Color fundus photograph; 45° FOV
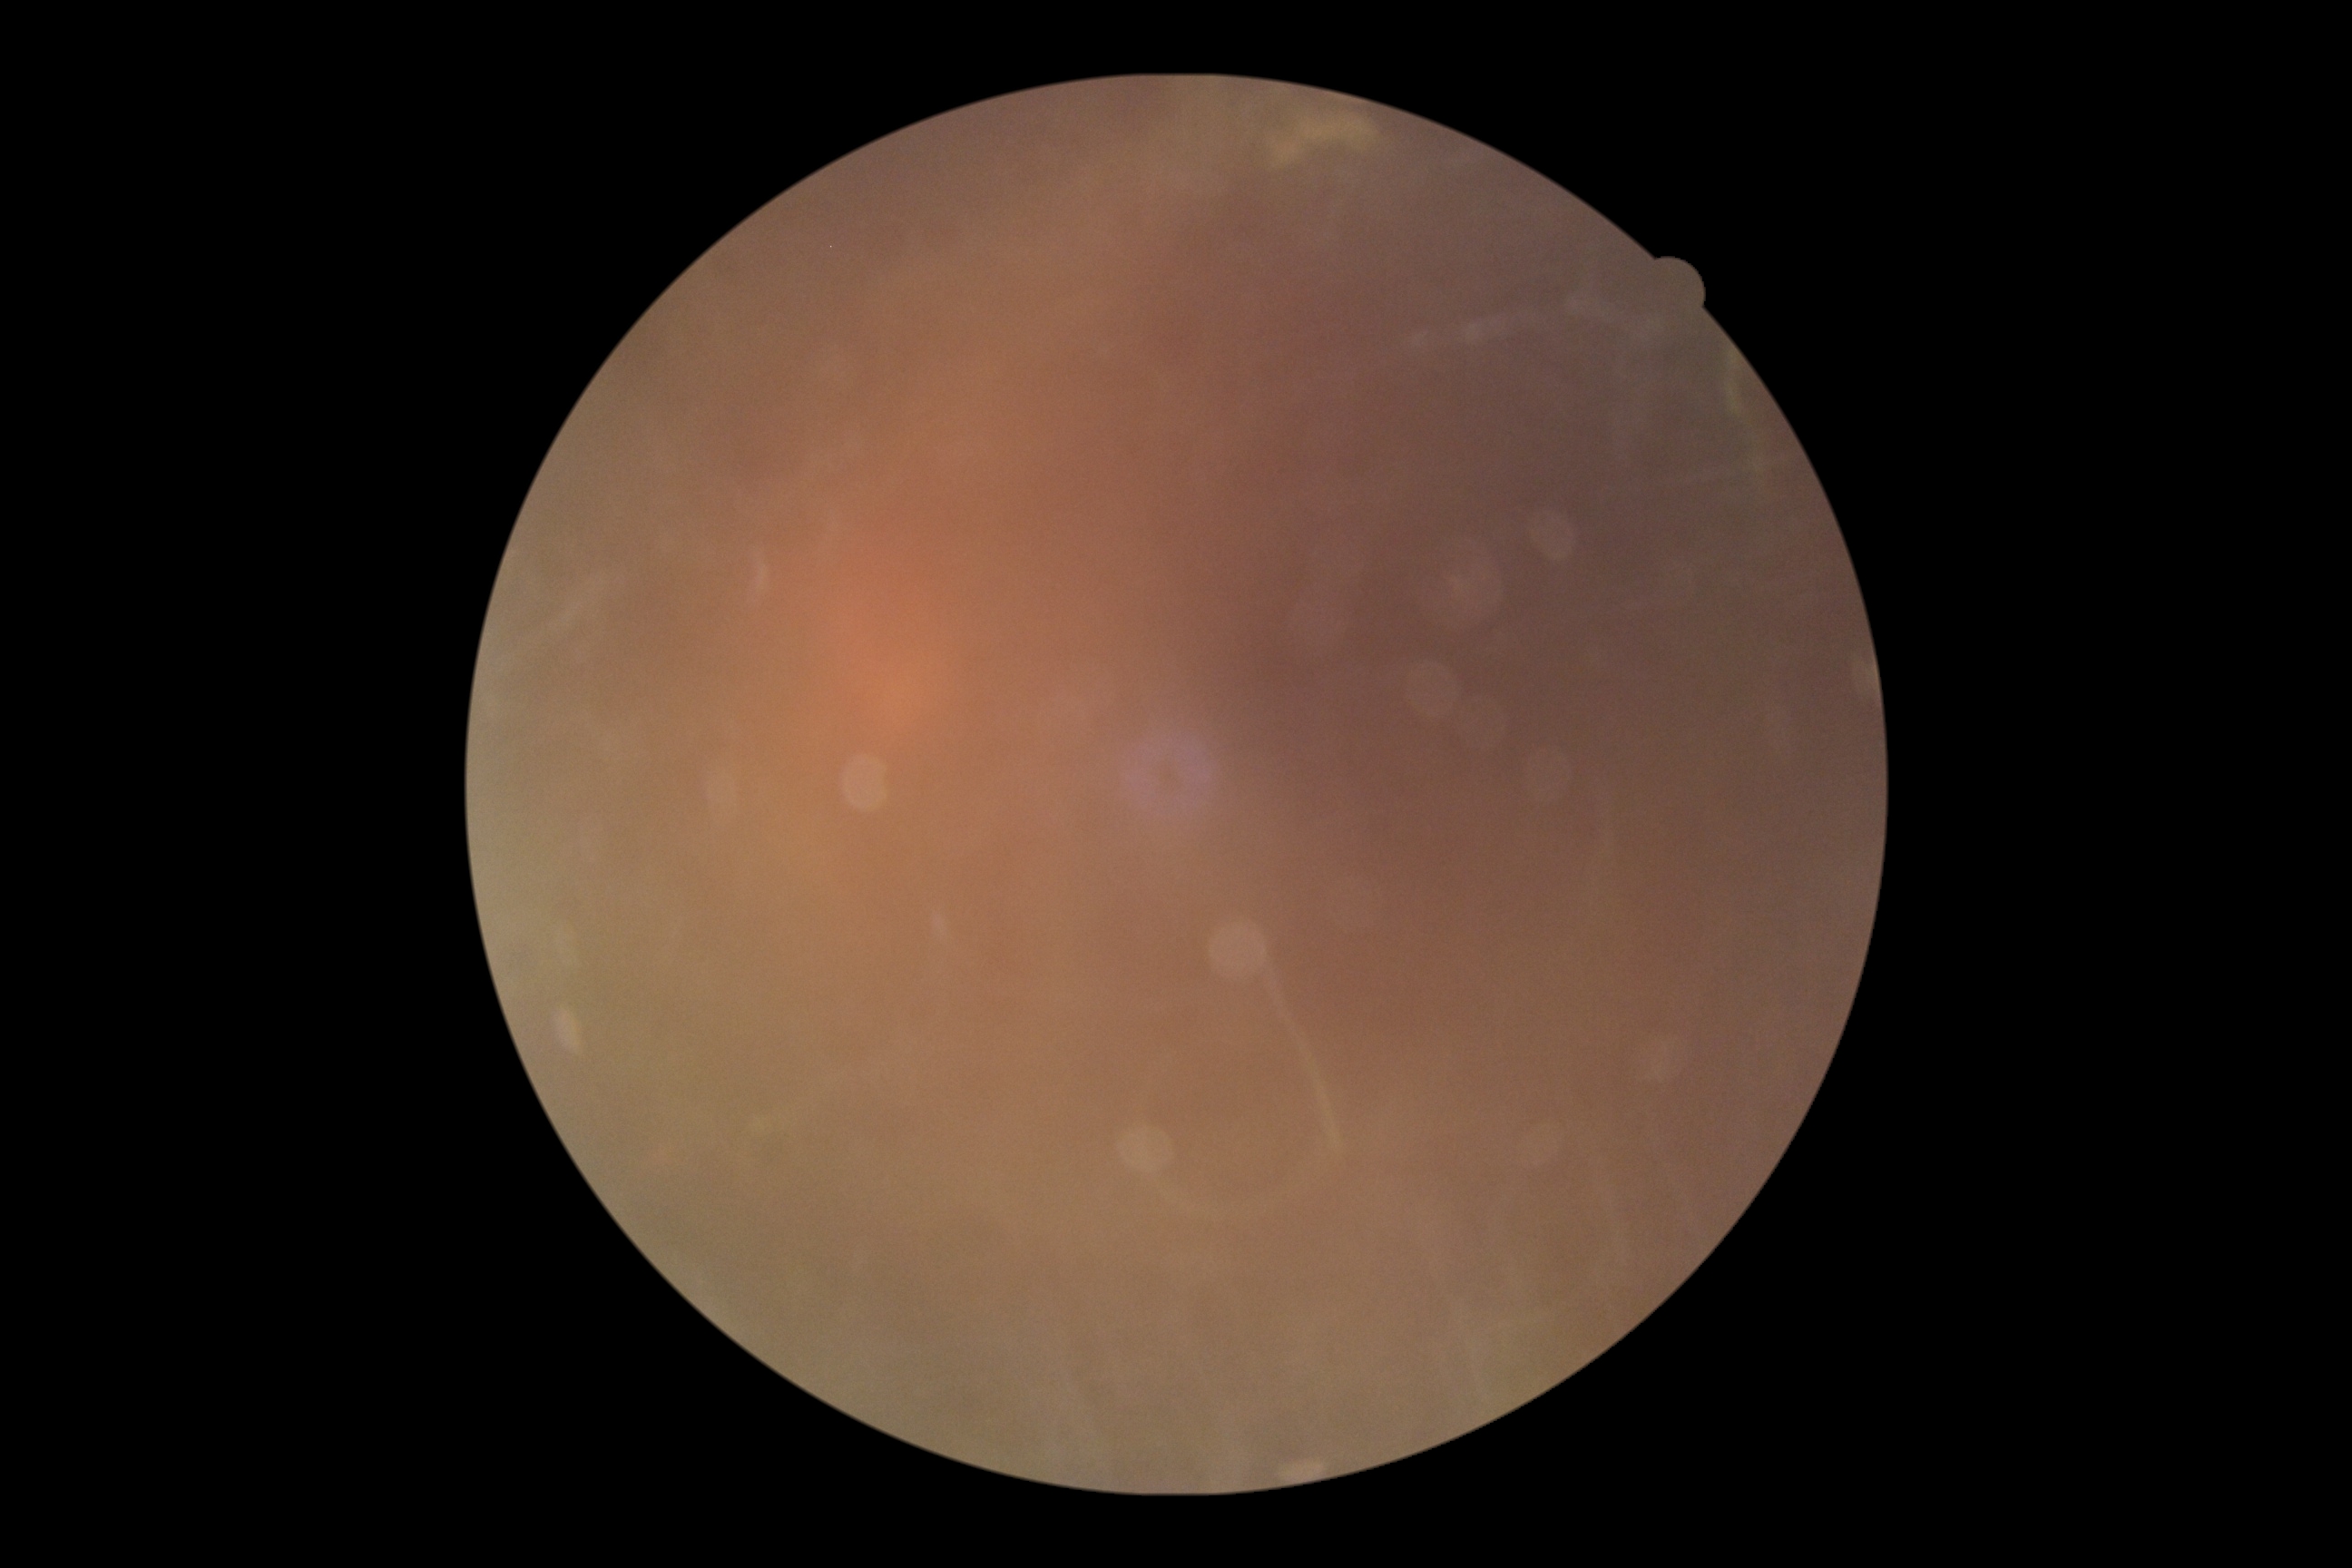

Retinopathy: ungradable due to poor image quality.
Ungradable image — DR severity cannot be determined.